Wide-field fundus photograph of an infant:
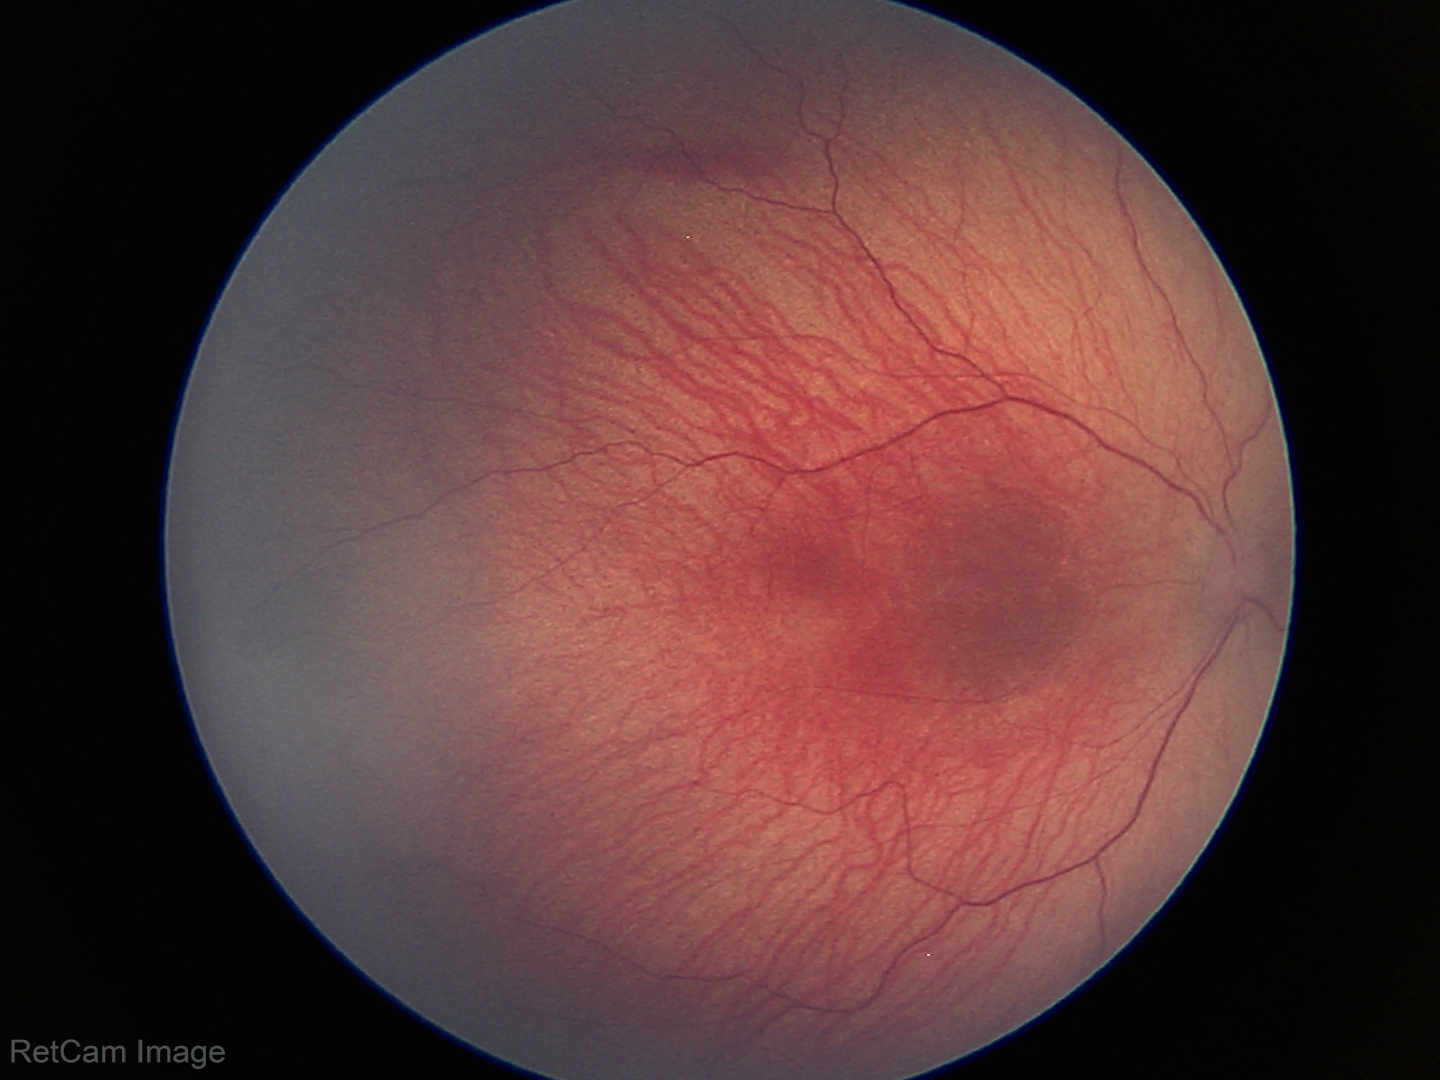 Examination diagnosed as ROP stage 1. Plus disease absent.